Captured with the Phoenix ICON (100° field of view); 1240 x 1240 pixels; pediatric wide-field fundus photograph
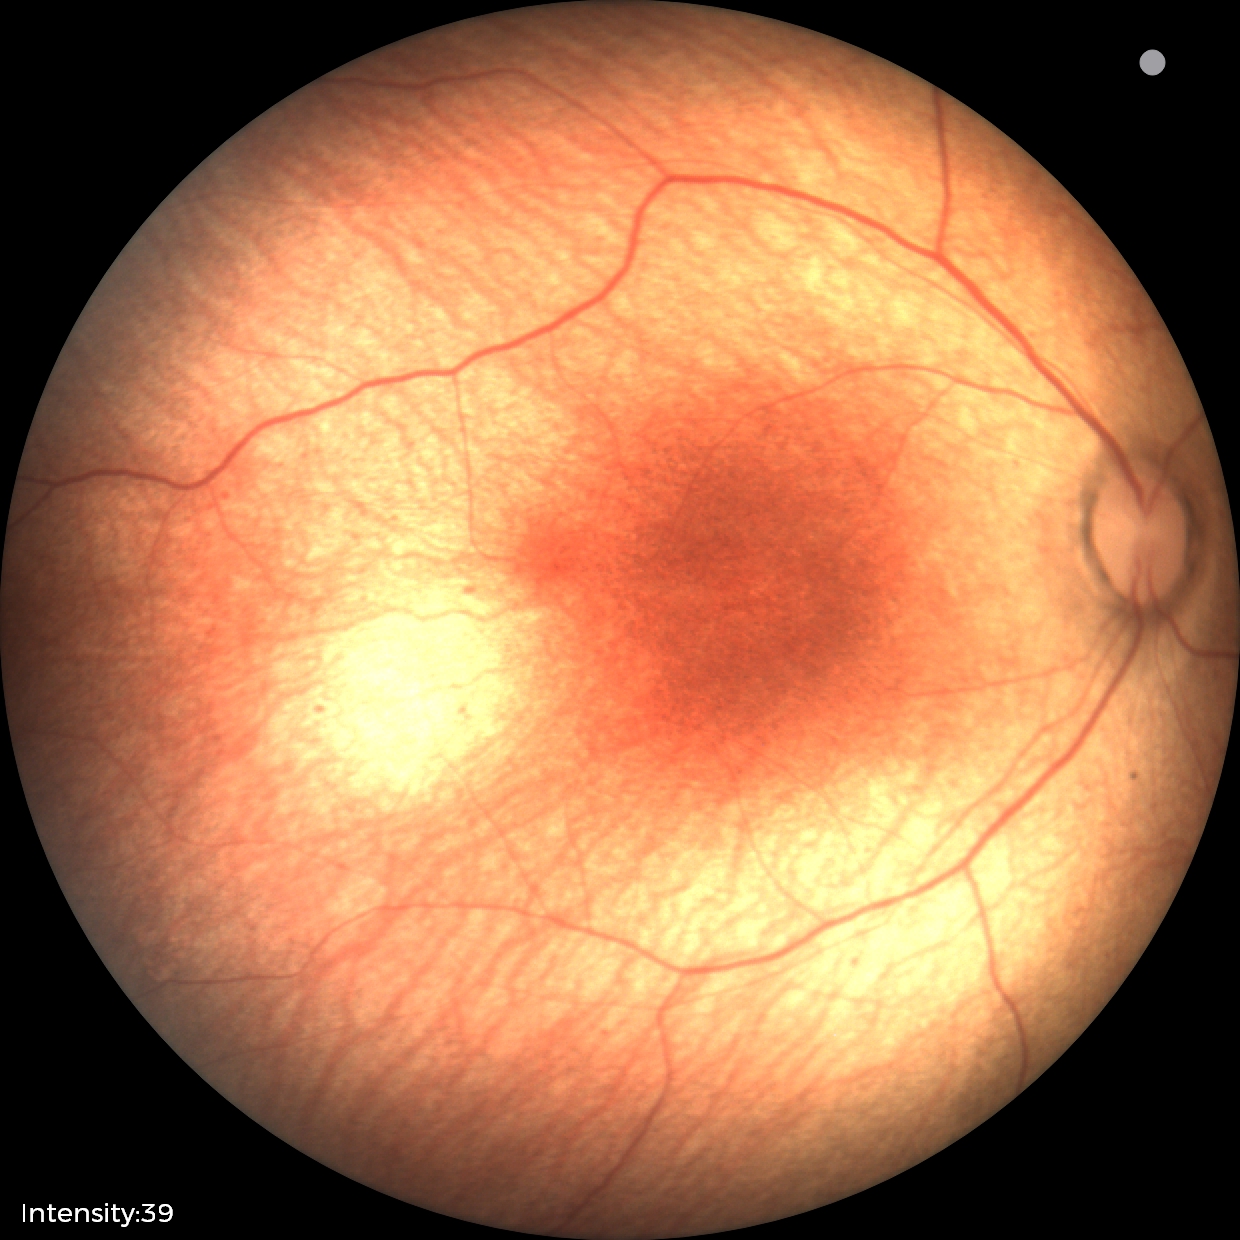
Examination with physiological retinal findings.